No pharmacologic dilation, modified Davis classification, 848x848px, fundus photo.
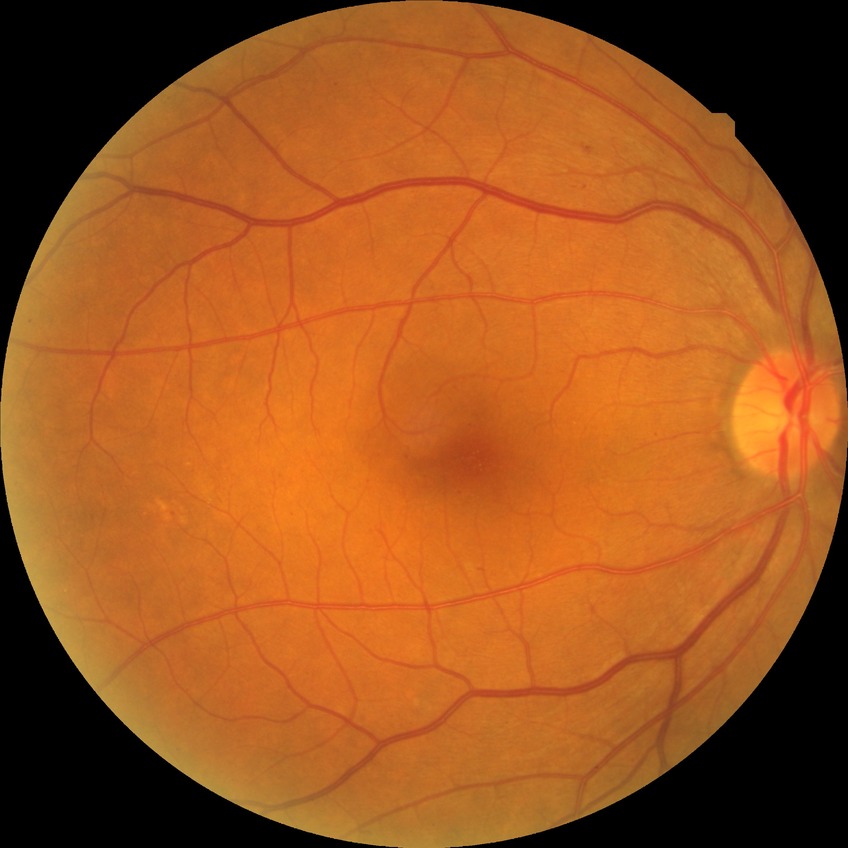
Assessment:
– DR class: non-proliferative diabetic retinopathy
– retinopathy stage: simple diabetic retinopathy